1932 x 1932 pixels — 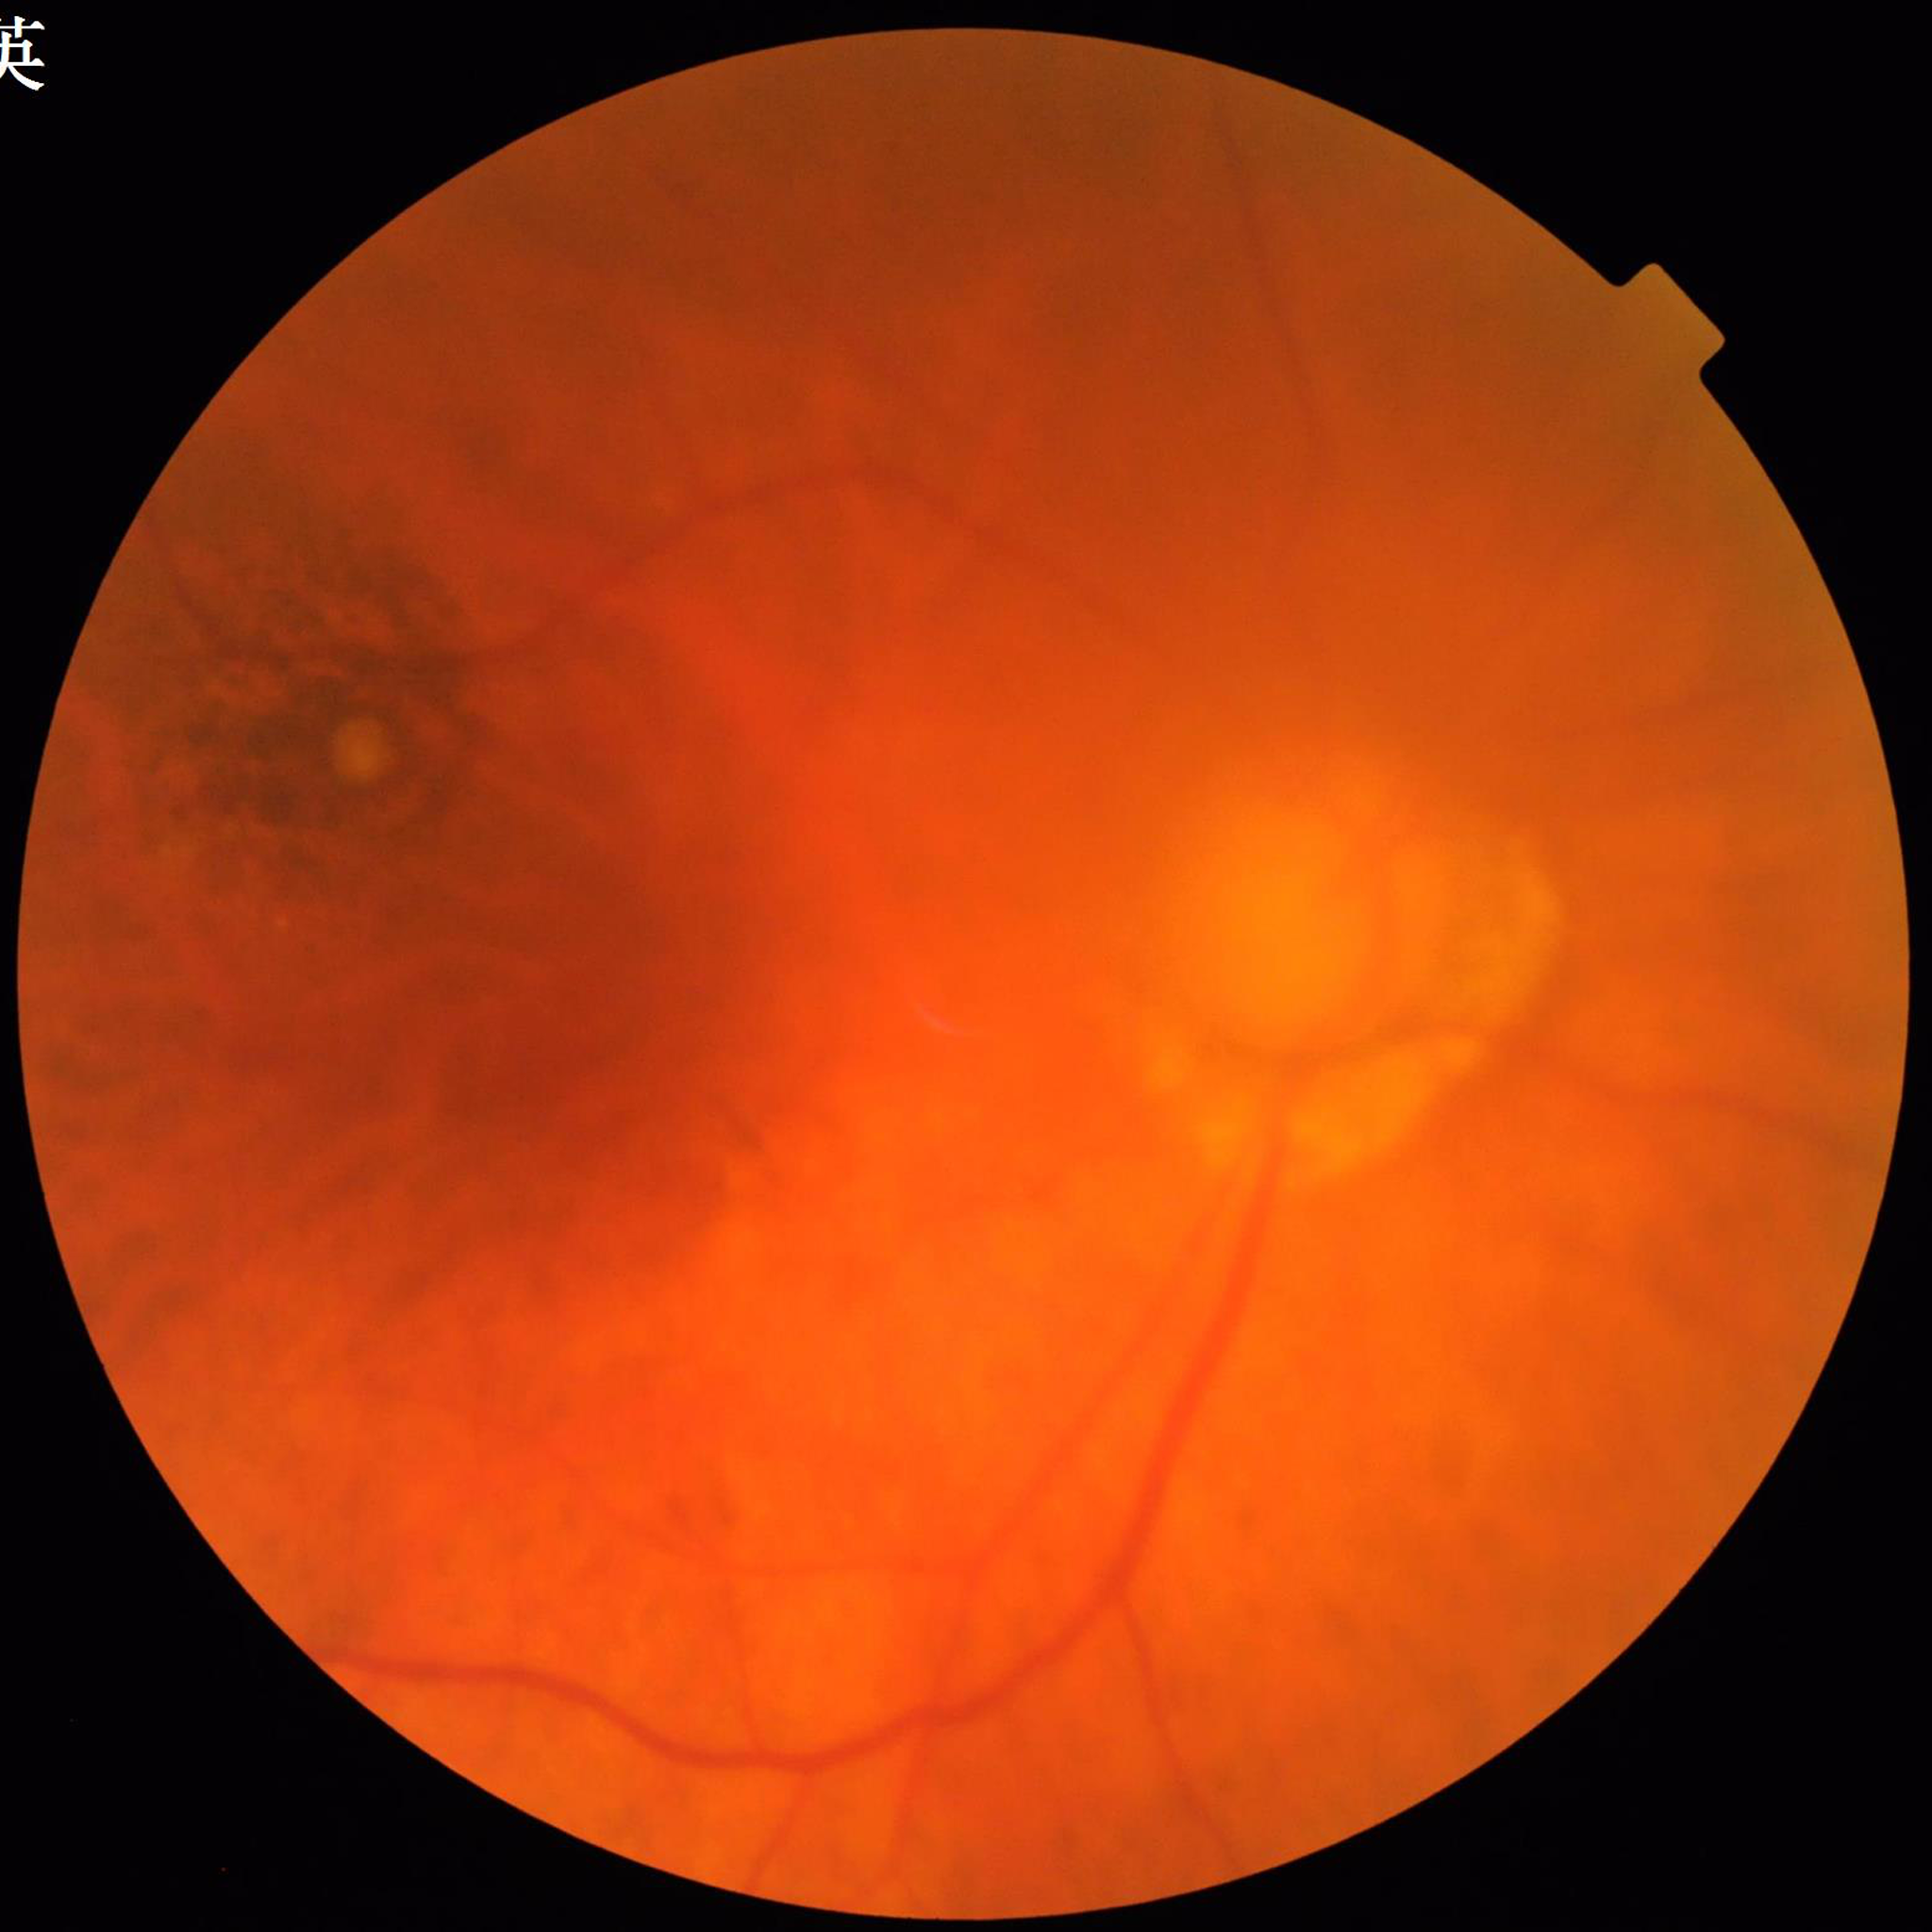
Fundus image of an eye with age-related macular degeneration. Quality: reduced — blur.